848x848. Nonmydriatic:
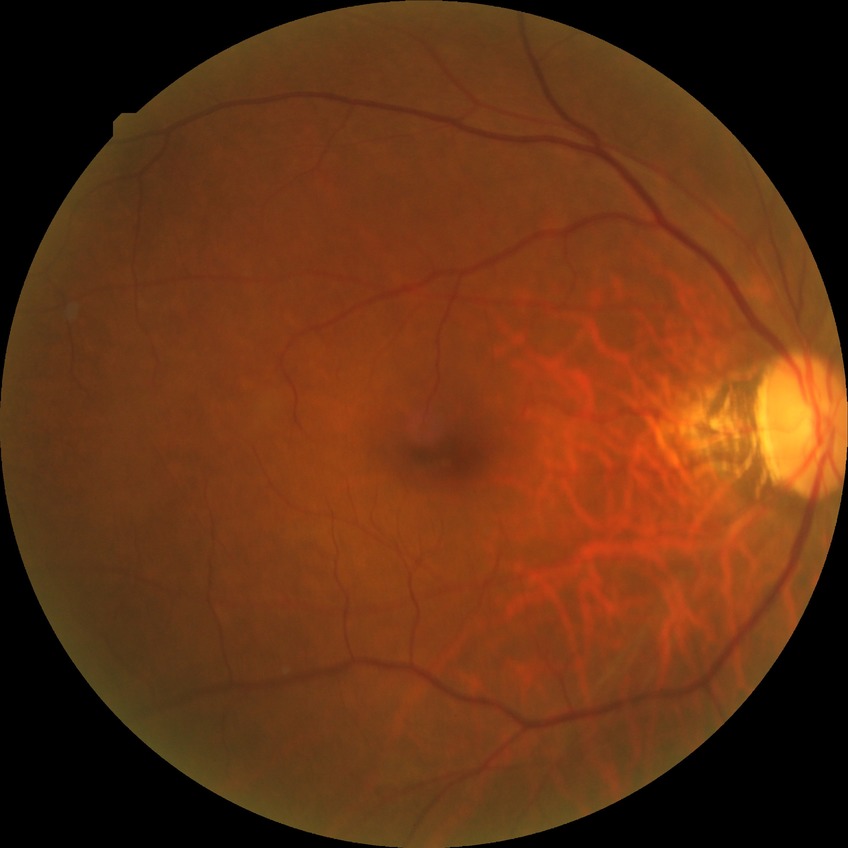 Modified Davis classification: no diabetic retinopathy.